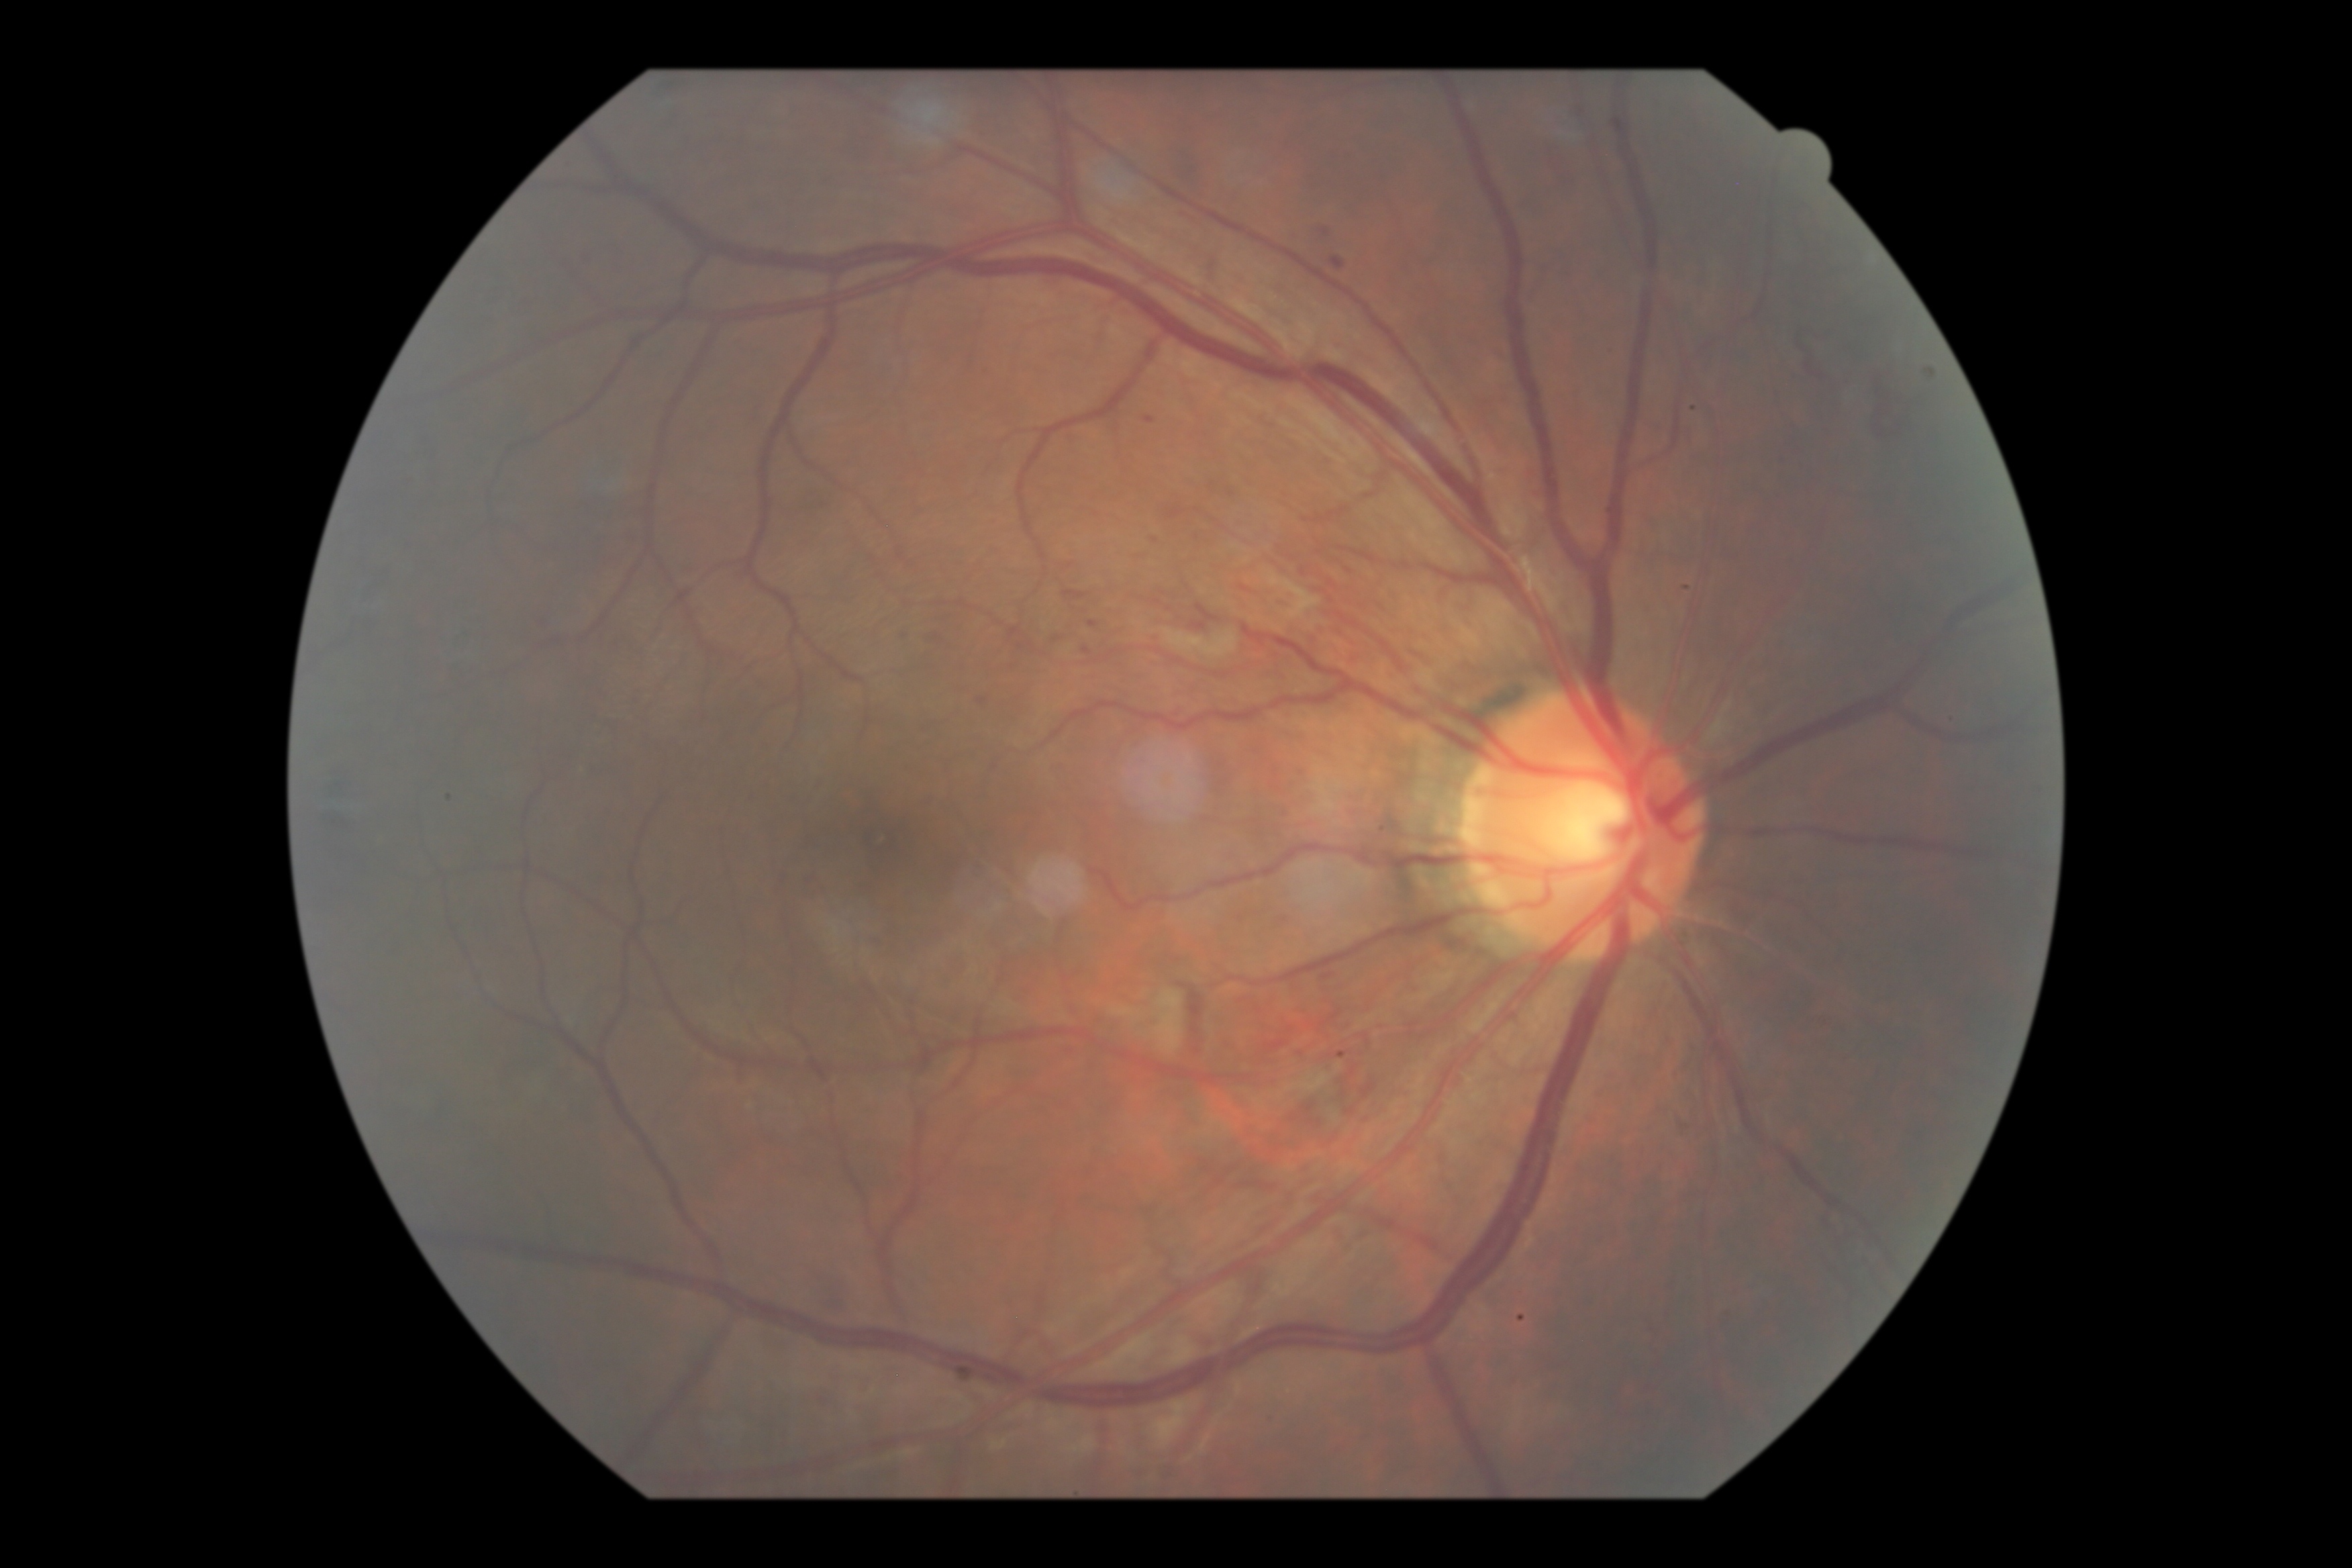 Annotations:
- DR — grade 2 (moderate NPDR)
- DR class — non-proliferative diabetic retinopathy